2212 by 1659 pixels.
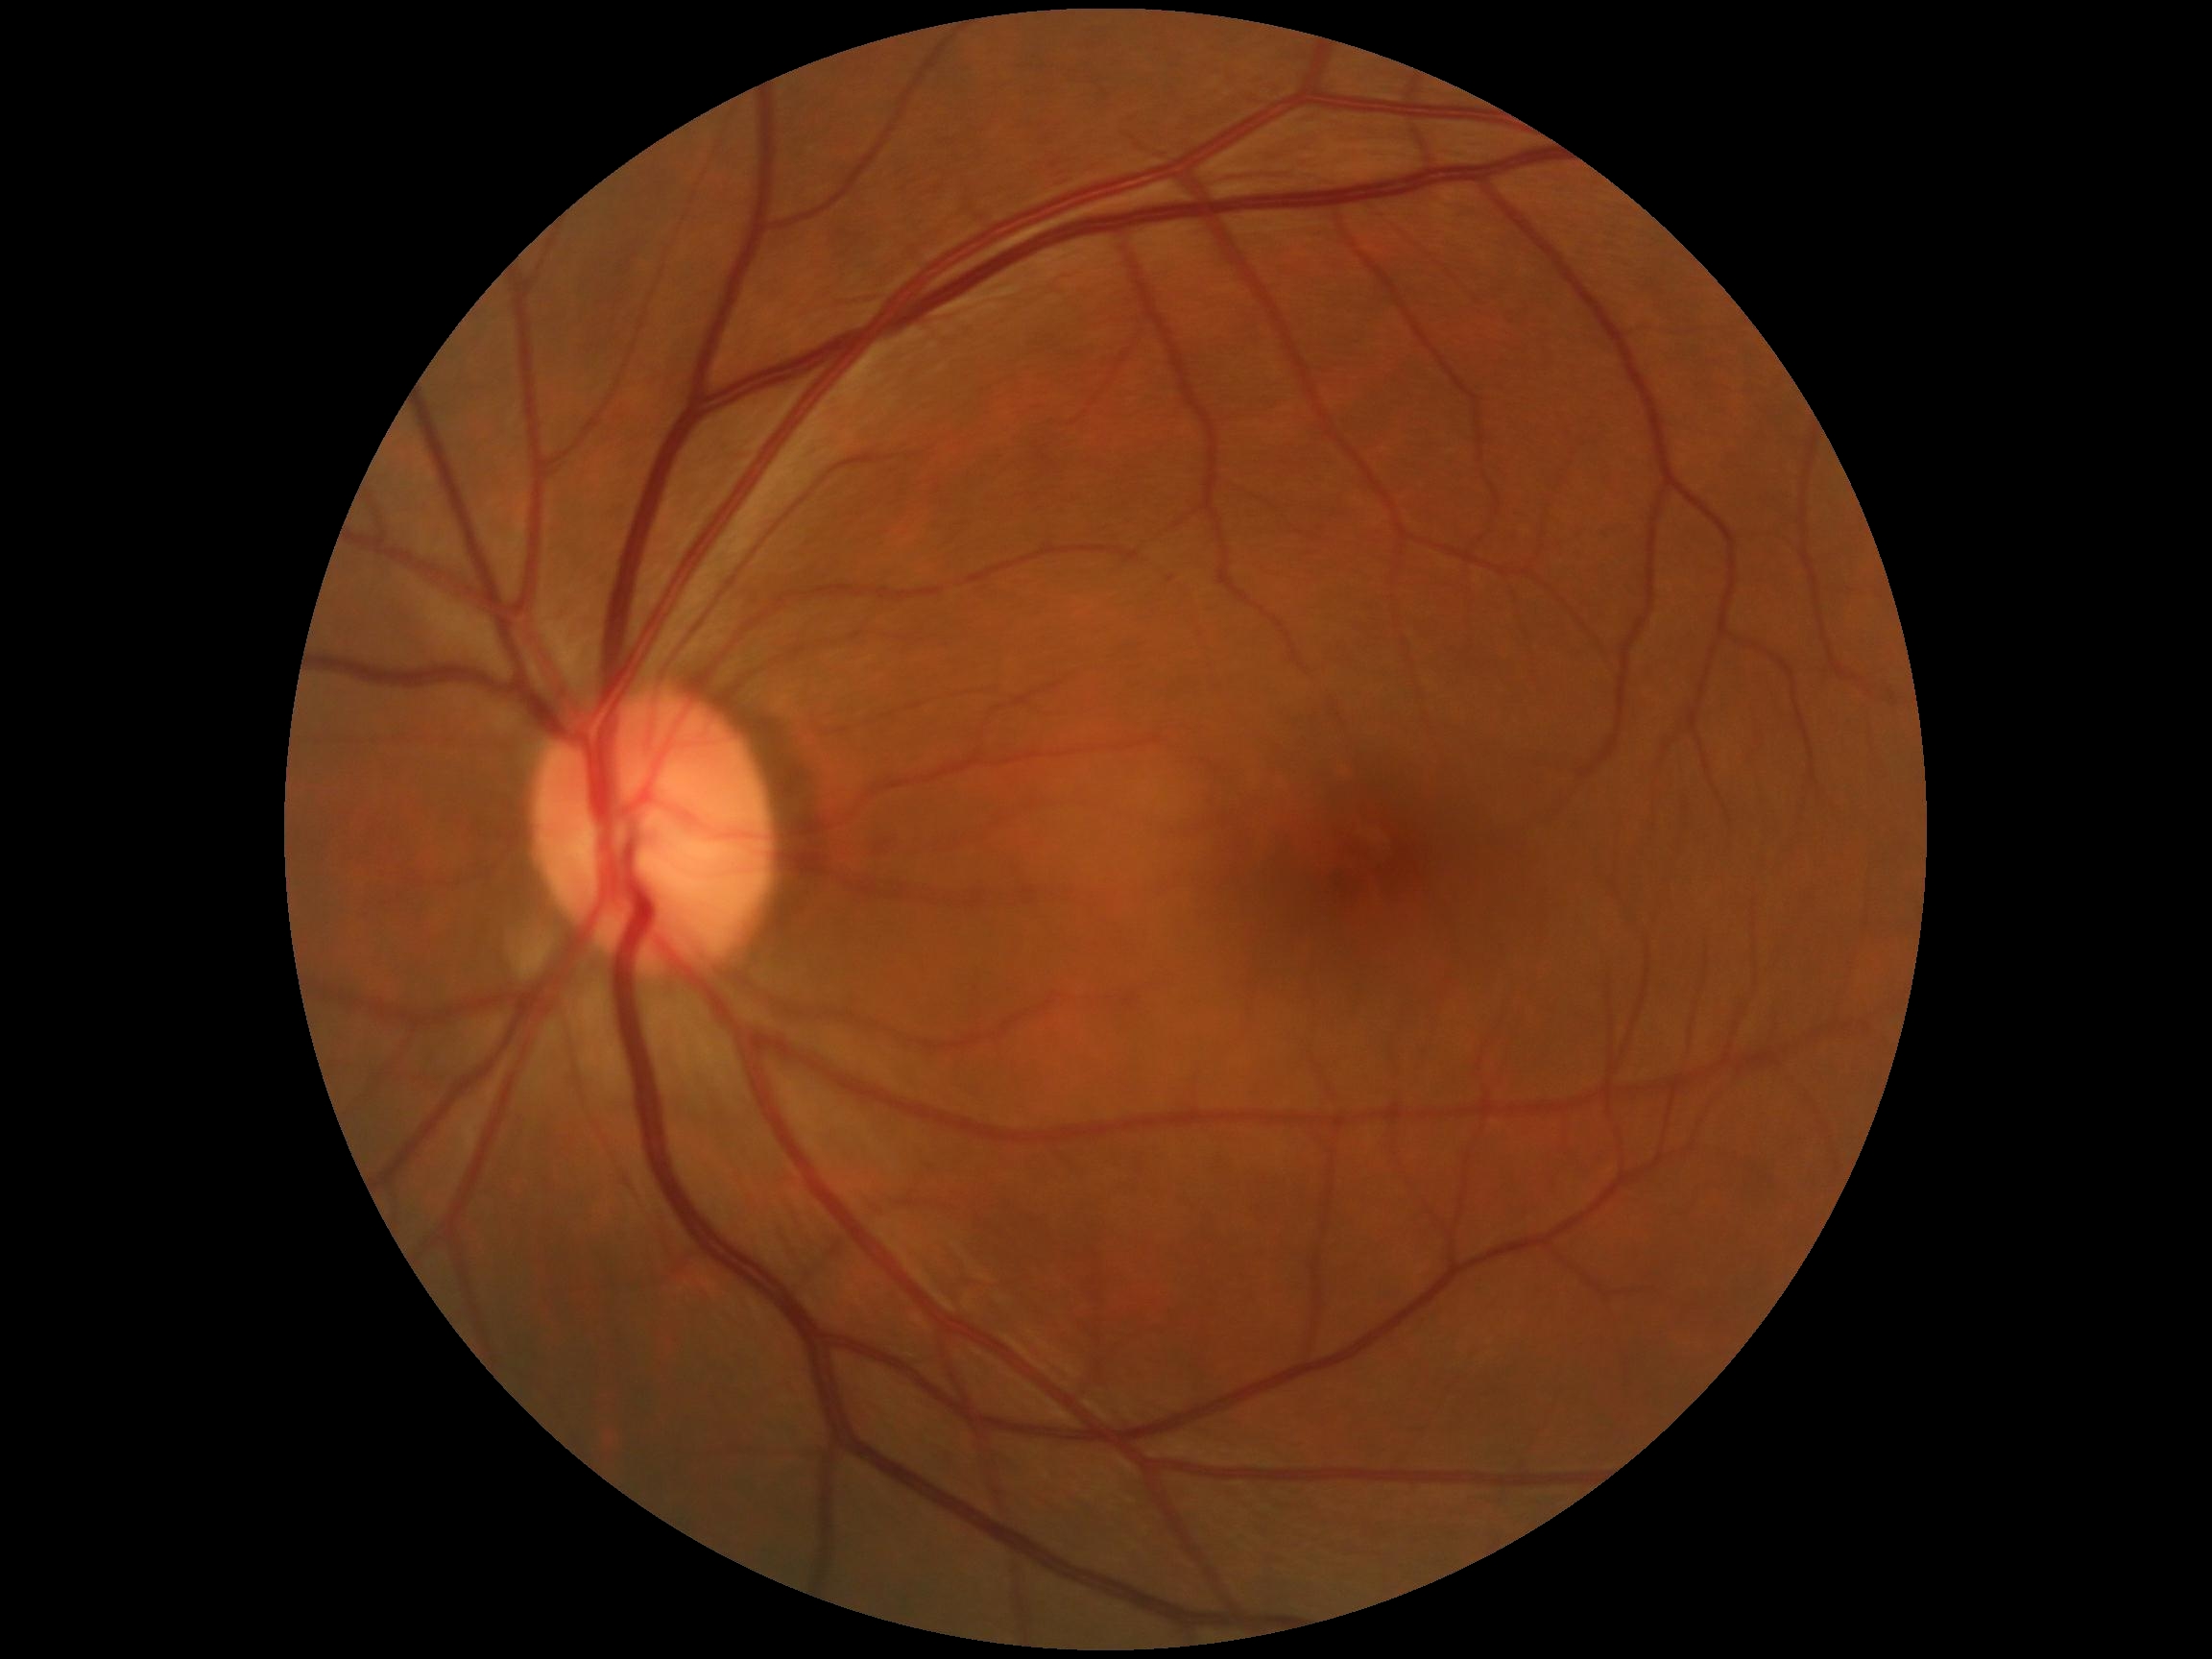
DR severity: grade 0 (no apparent retinopathy).